FOV: 45 degrees; color fundus photograph: 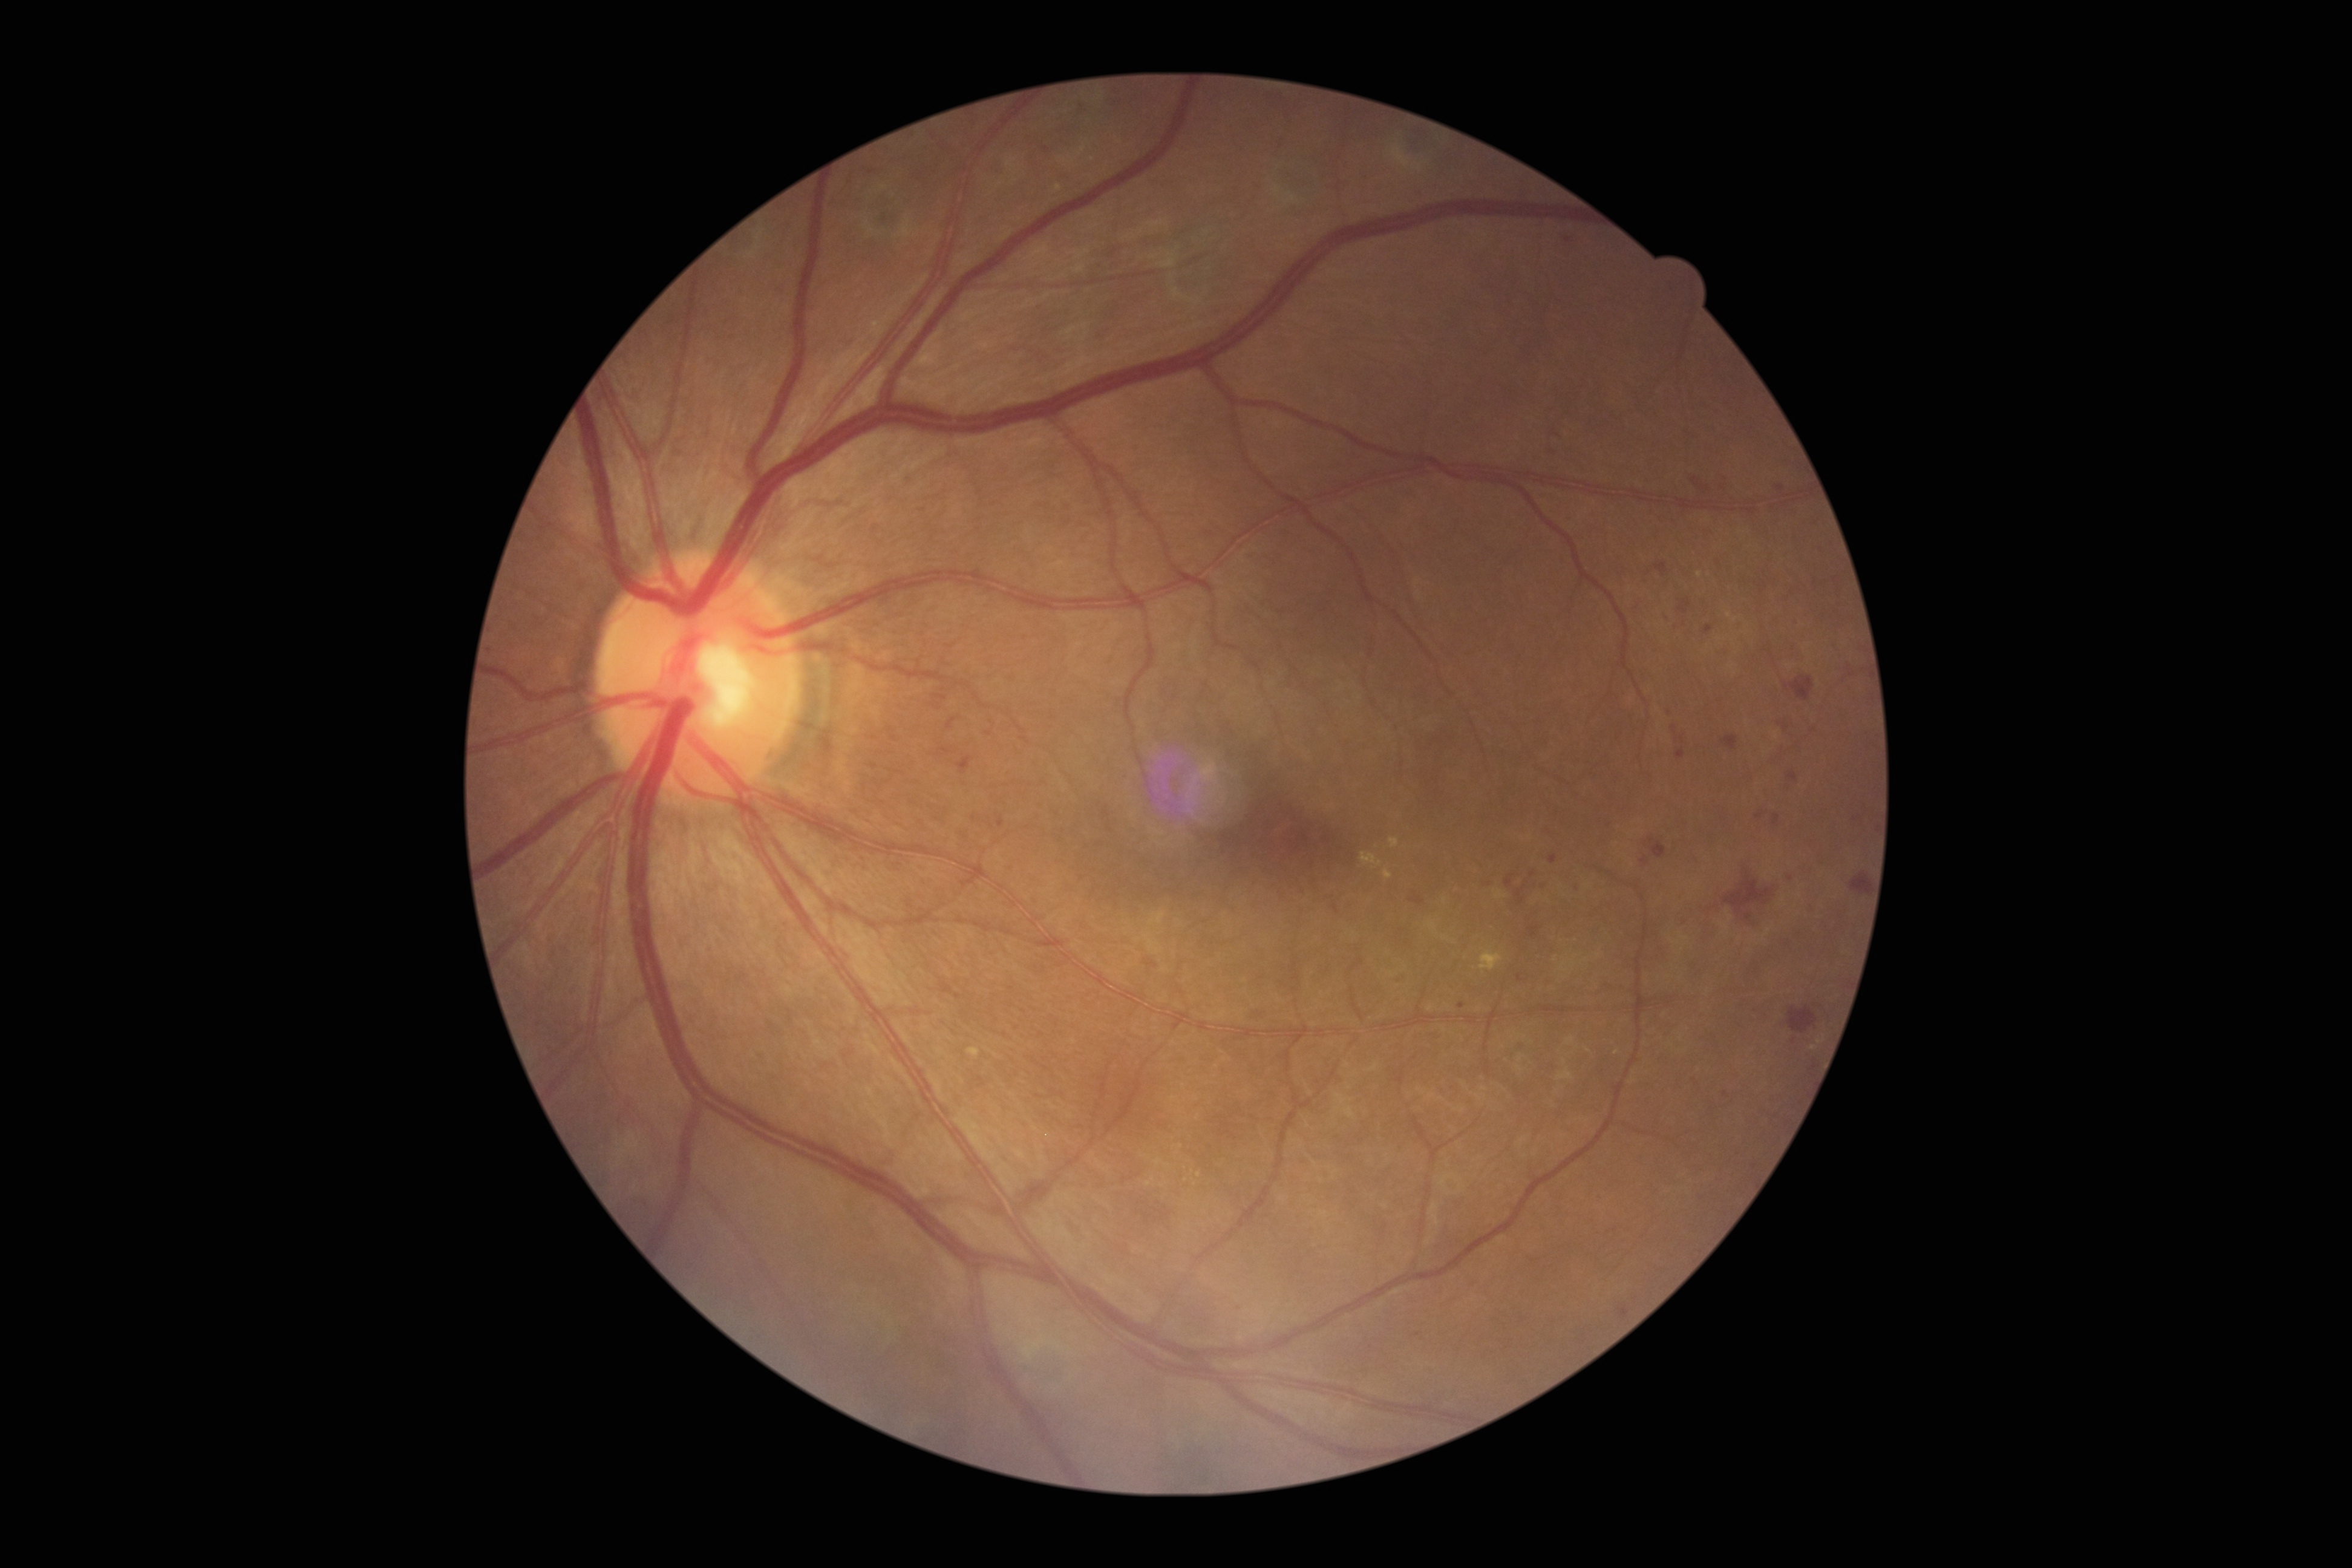 DR severity@2/4.